Non-mydriatic; centered on the optic disc; fundus photo
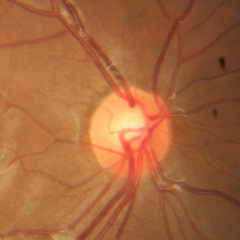
Impression: no glaucoma.